Modified Davis classification, retinal fundus photograph: 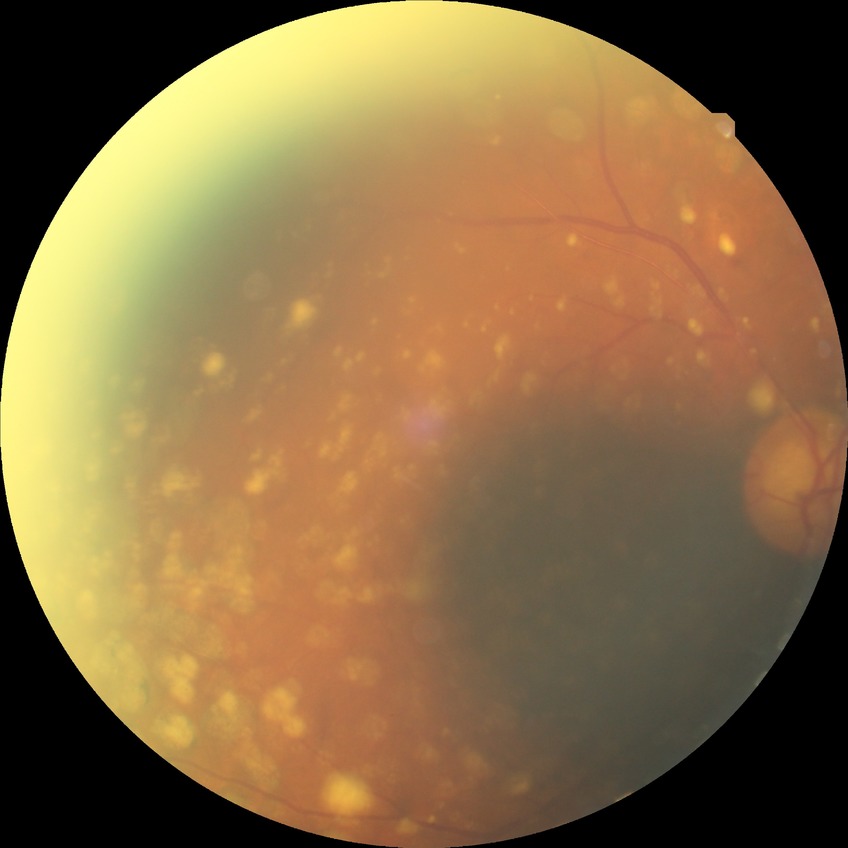

DR severity: PDR.